640x480px; wide-field contact fundus photograph of an infant:
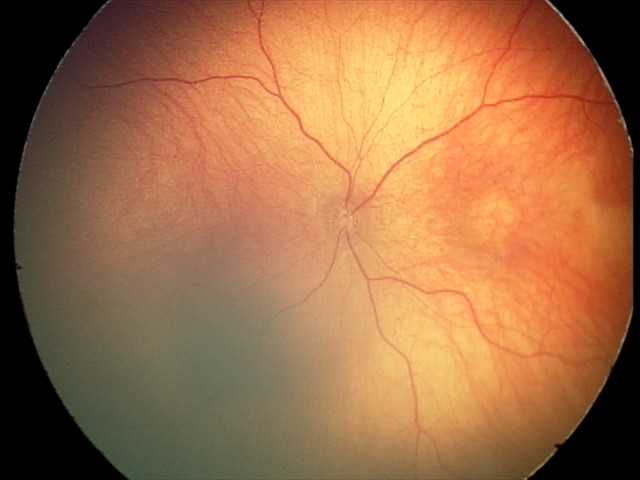
Assessment = optic nerve hypoplasia.